Retinal fundus photograph: 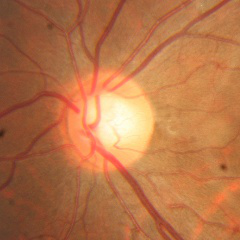
Optic disc appearance consistent with no evidence of glaucoma.